Centered on the optic disc; 30-degree field of view; captured on a Topcon TRC-NW400 fundus camera; non-mydriatic acquisition: 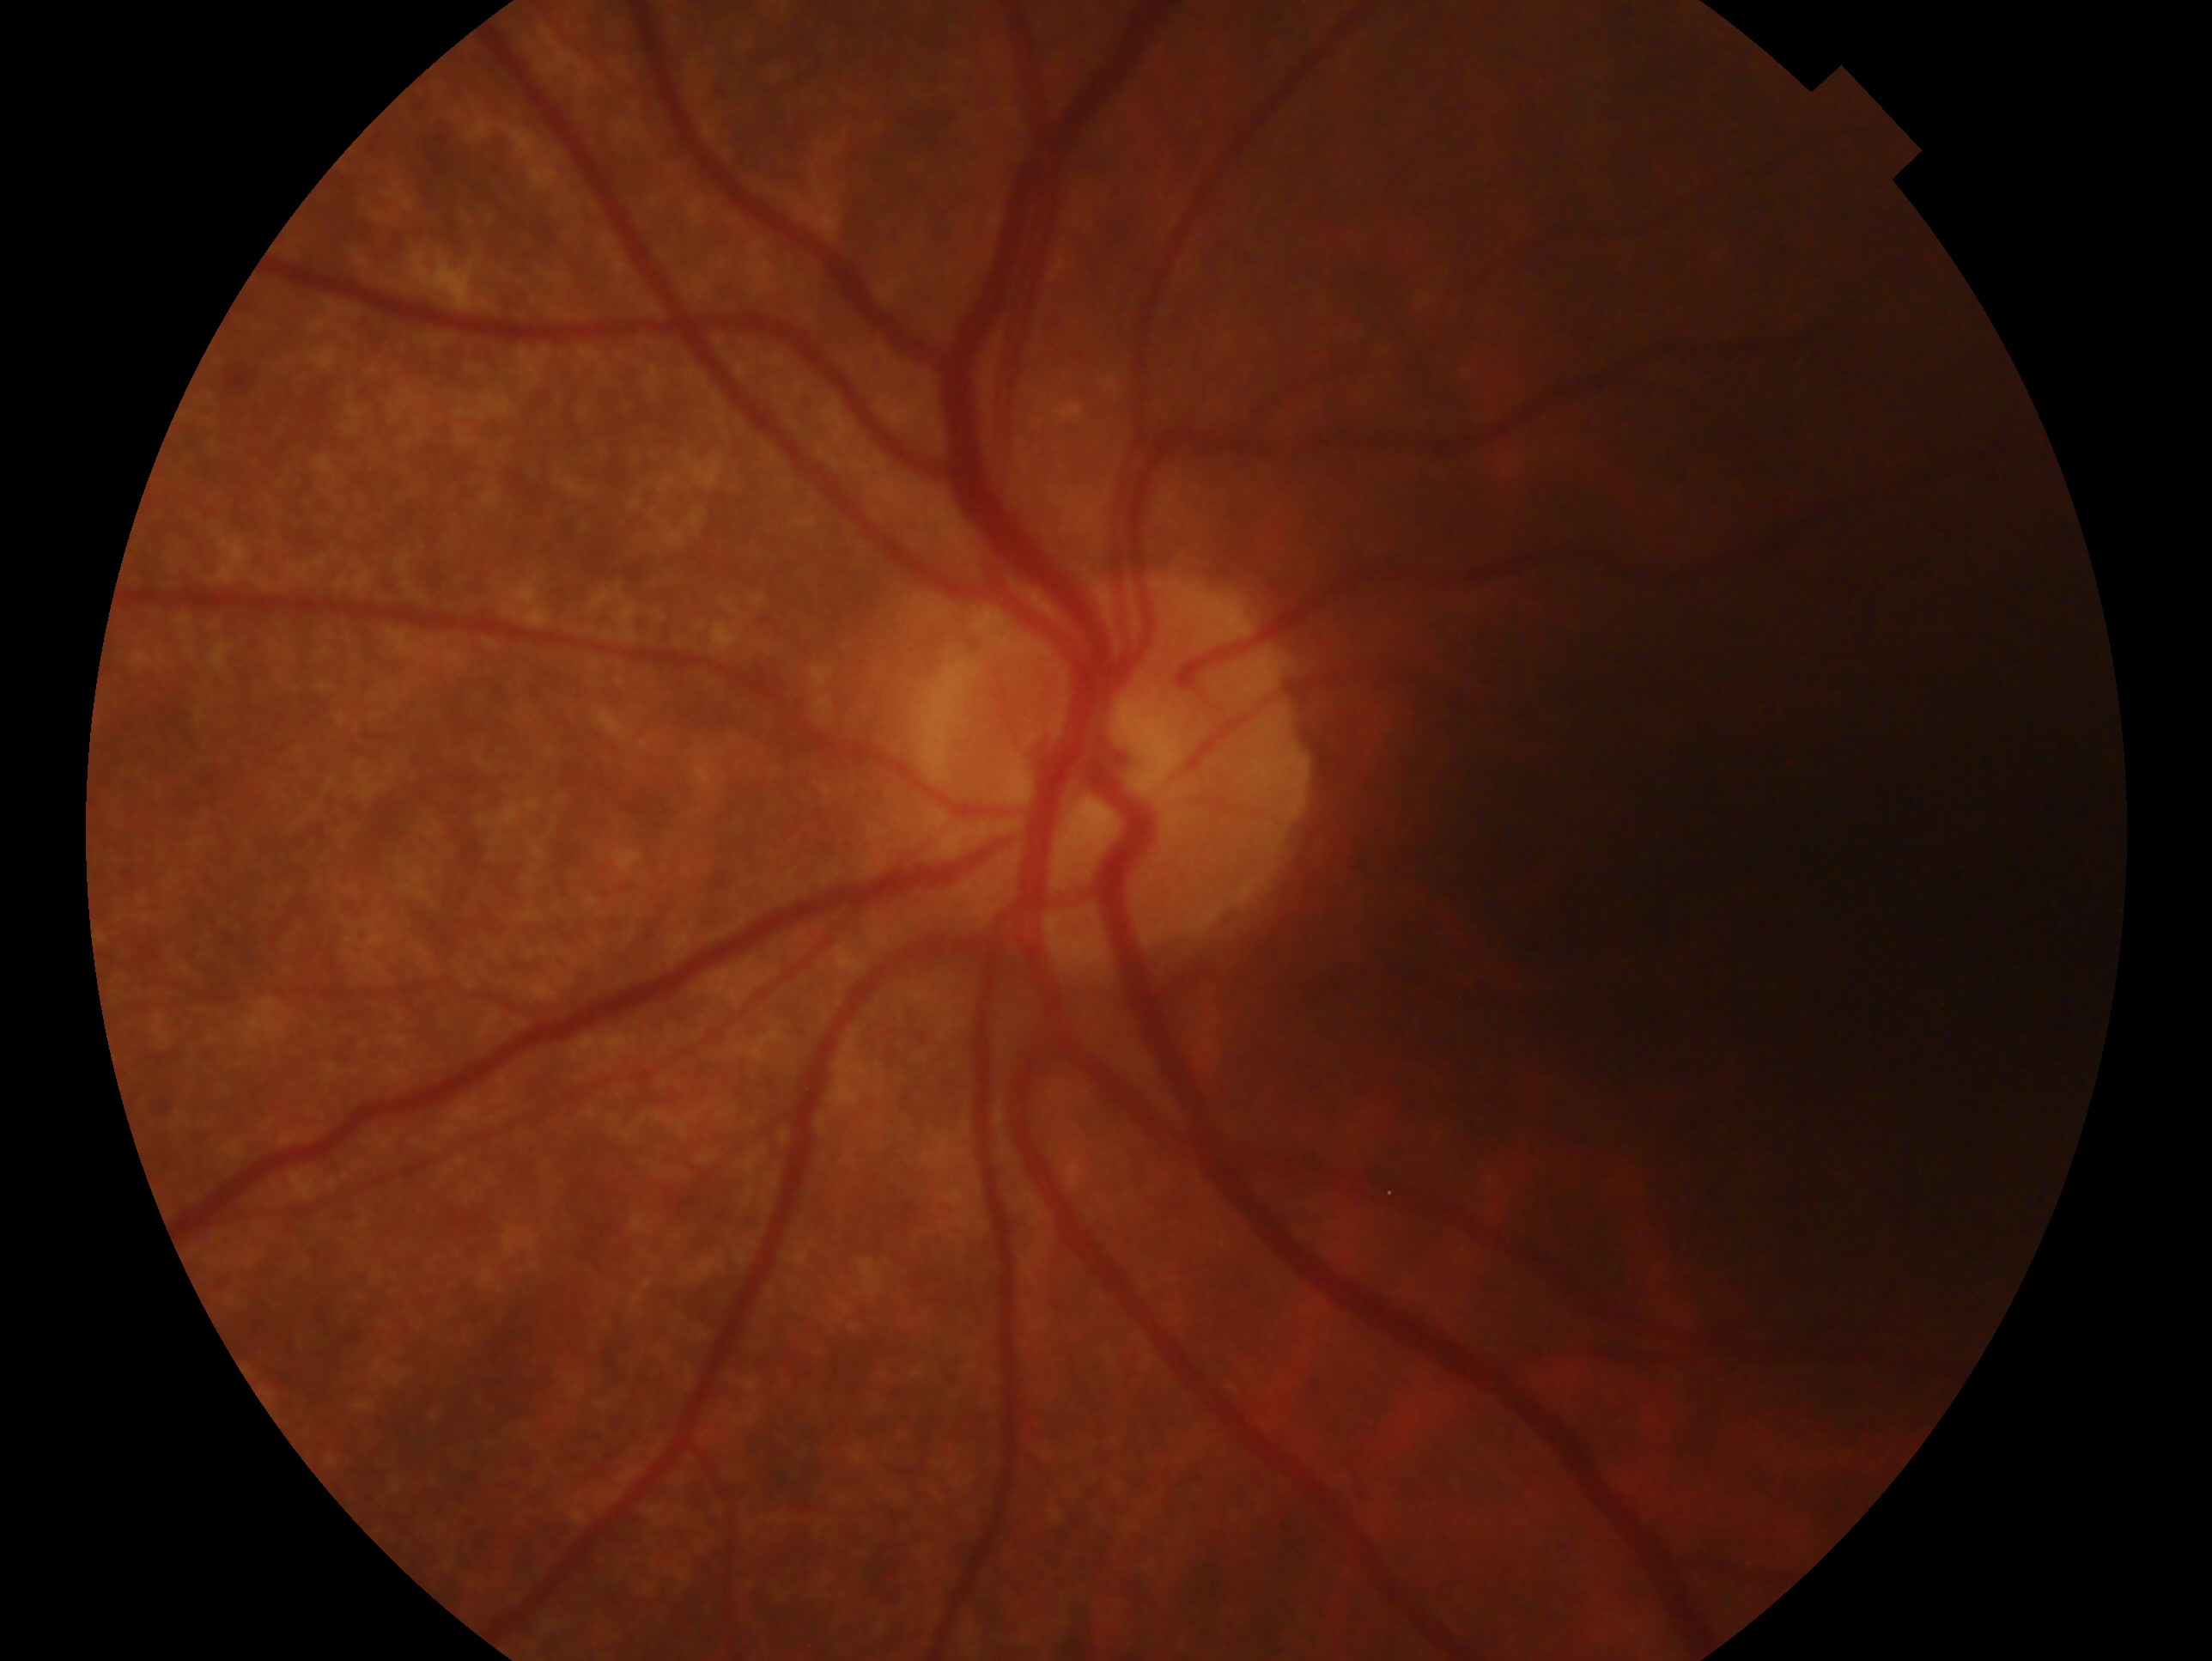

laterality: left | diagnosis: no glaucomatous findings.